Posterior pole photograph, Davis DR grading, FOV: 45 degrees:
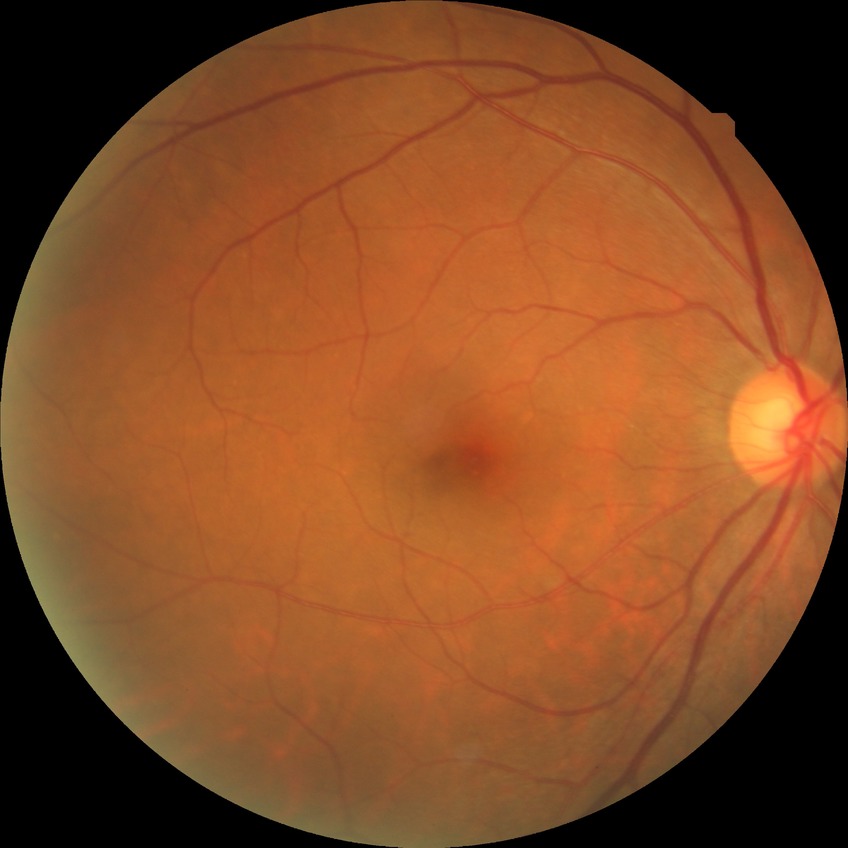
diabetic retinopathy stage: no diabetic retinopathy.